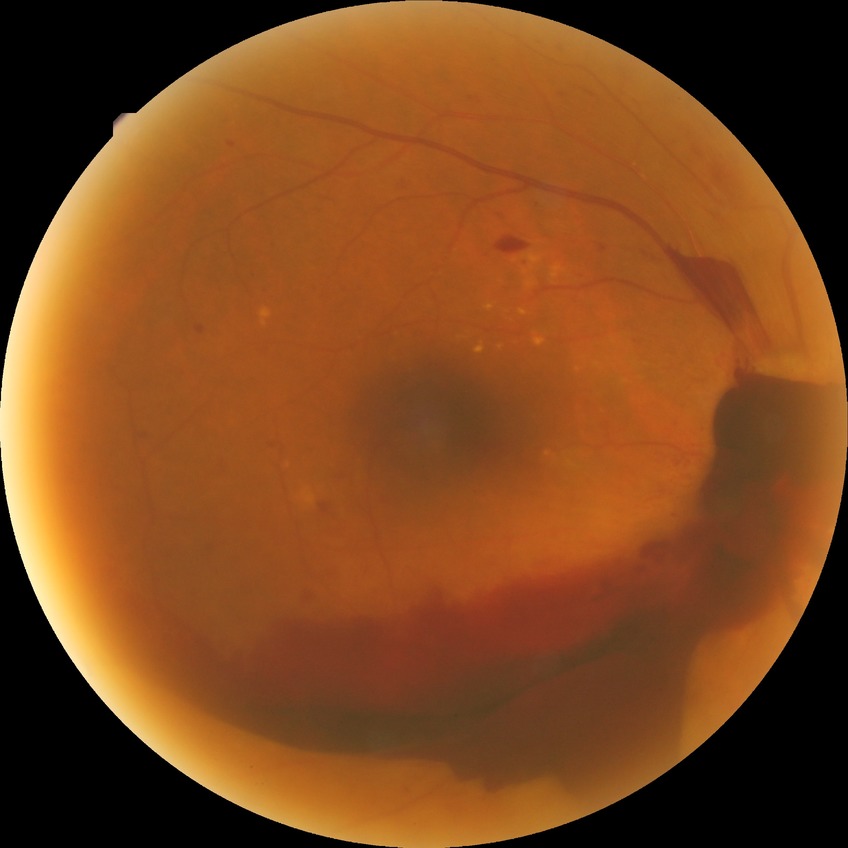 diabetic retinopathy (DR): PDR (proliferative diabetic retinopathy).